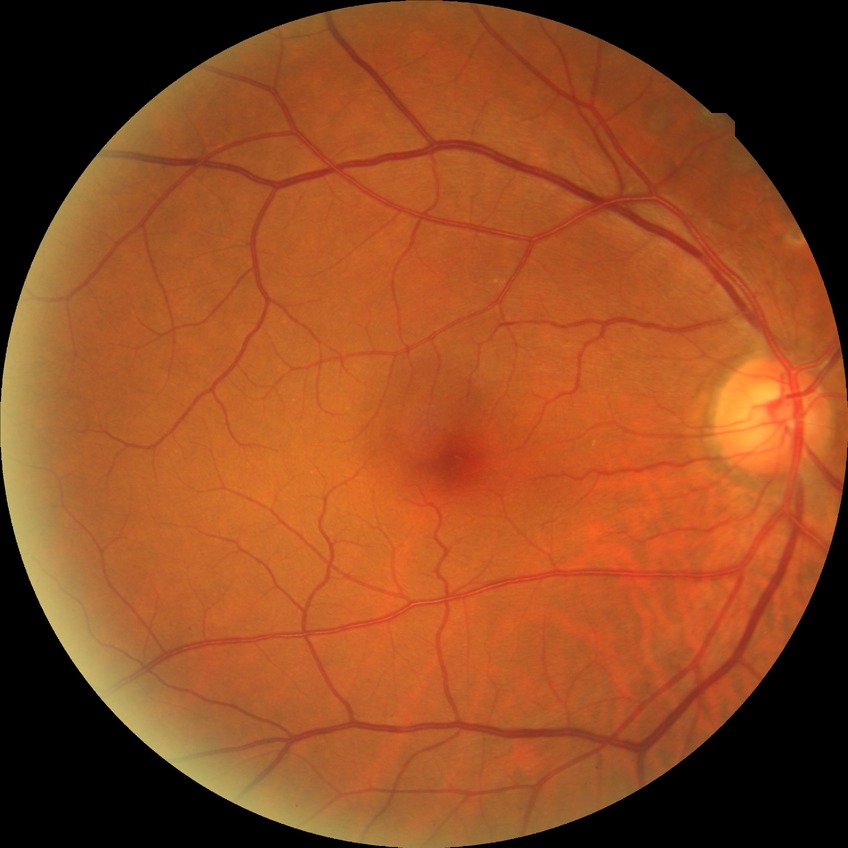

Modified Davis grading is no diabetic retinopathy.